45-degree field of view: 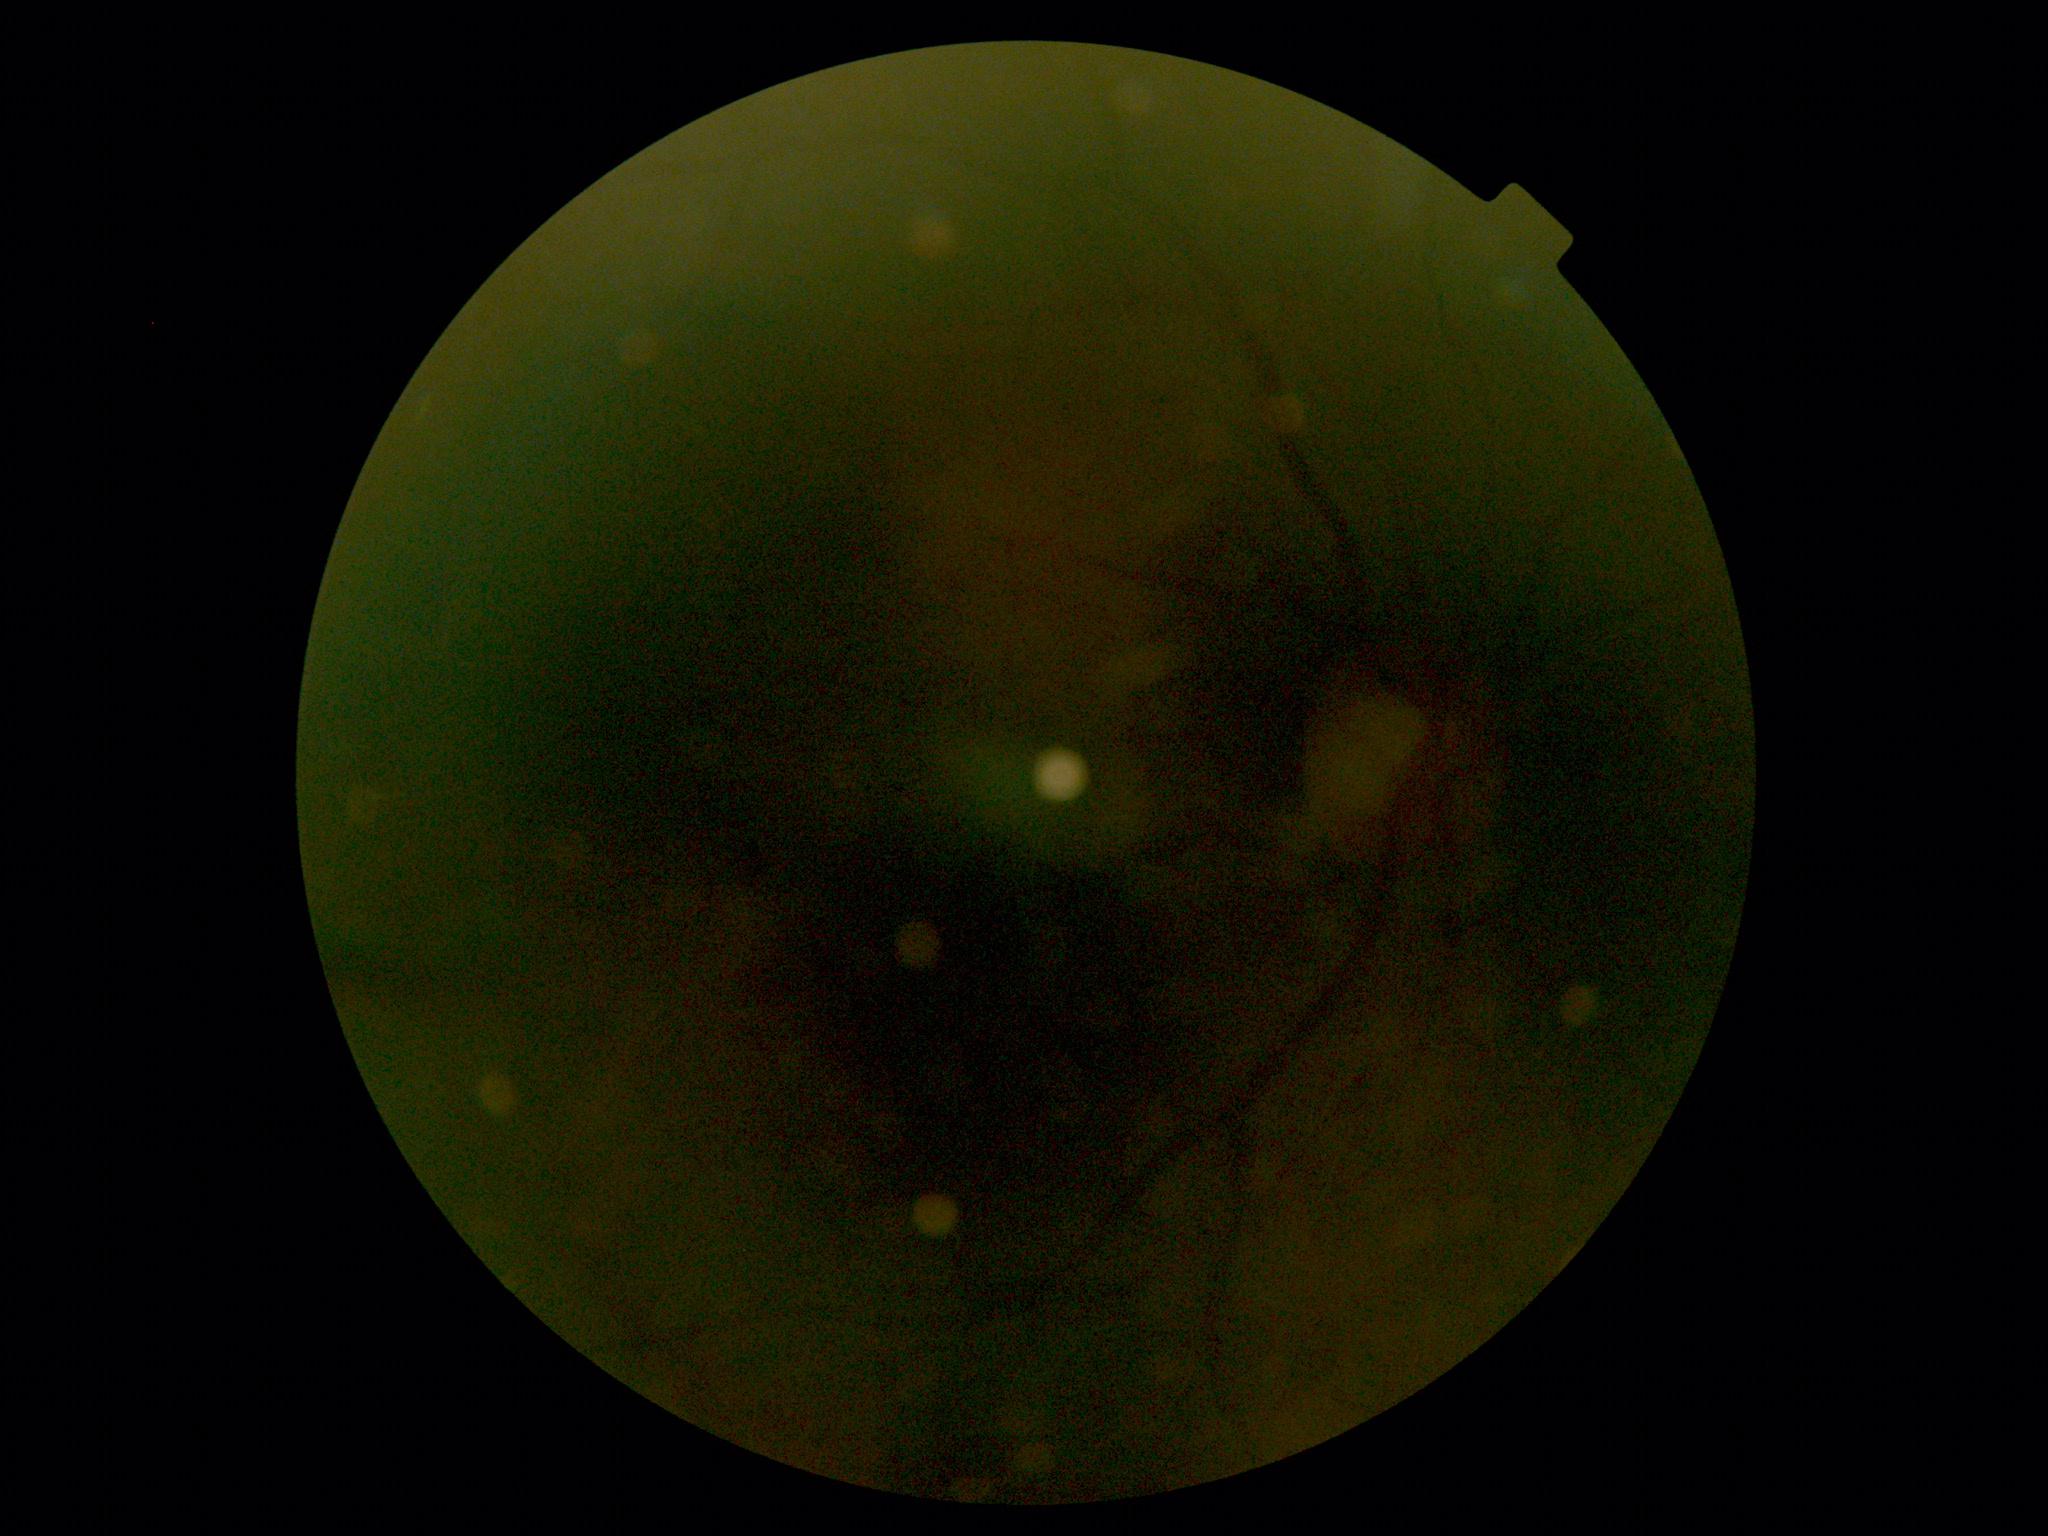
Quality too poor to assess for DR. DR severity: ungradable.